Infant wide-field fundus photograph
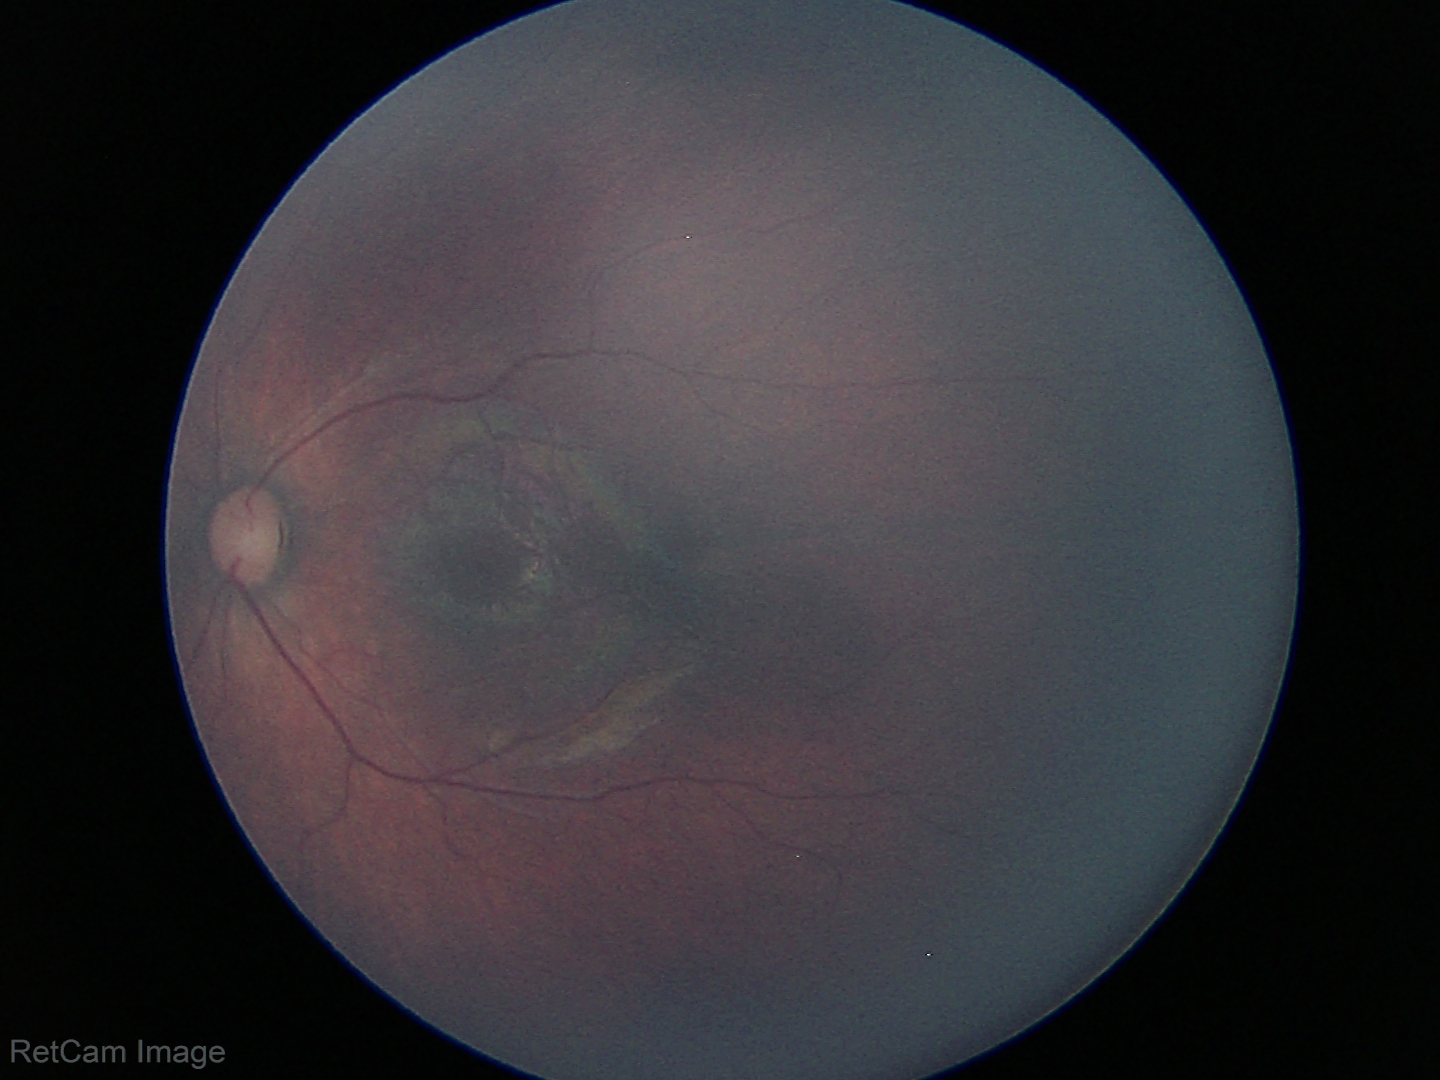

Physiological retinal appearance for postconceptual age.